Clarity RetCam 3, 130° FOV · 640x480 · wide-field fundus image from infant ROP screening.
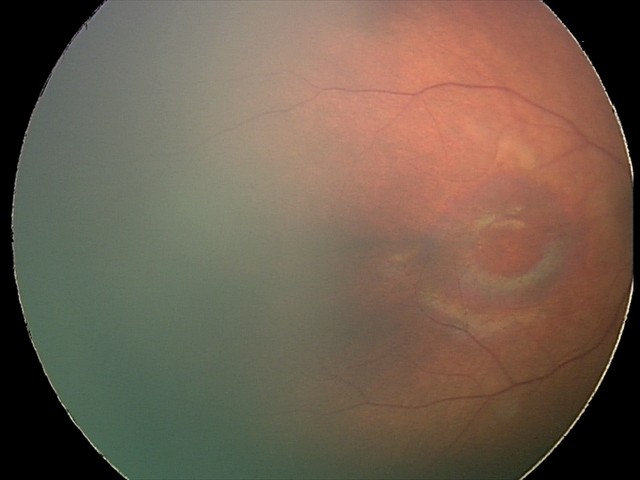 Examination with physiological retinal findings.